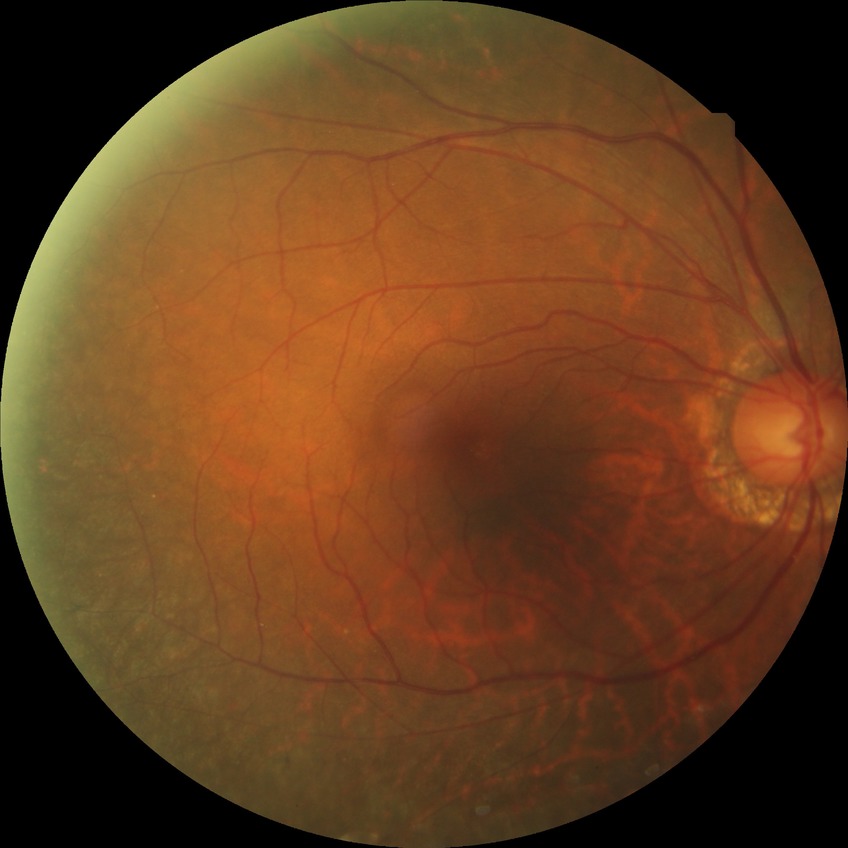 Davis grading: no diabetic retinopathy.